Phoenix ICON wide-field infant fundus image.
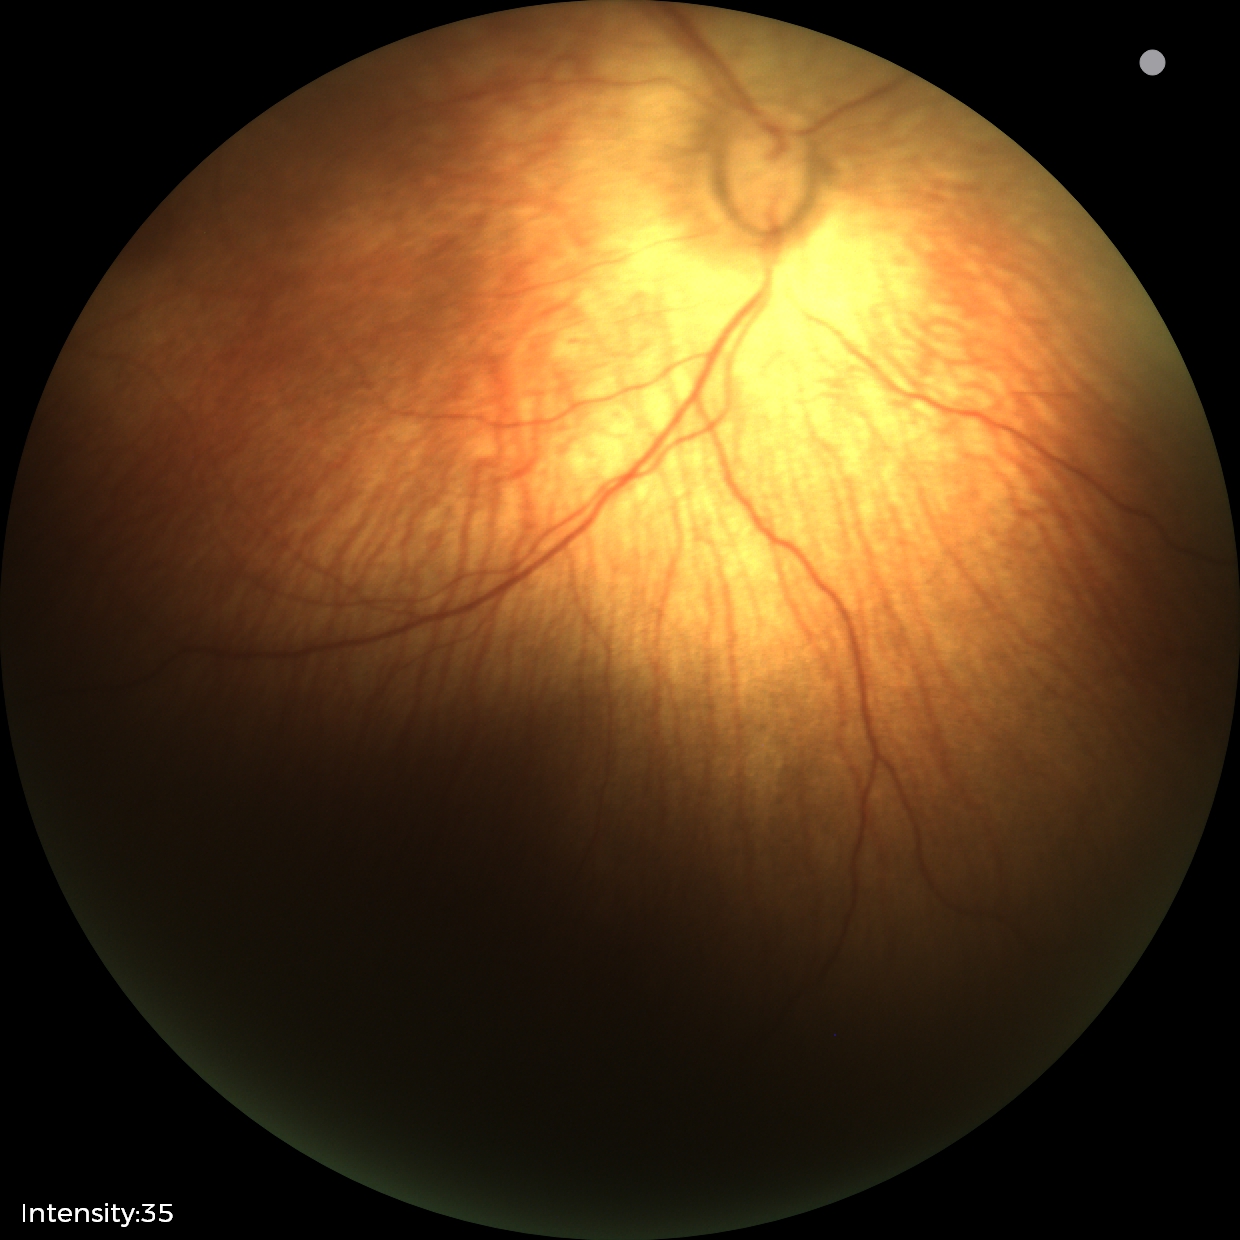 Diagnosis from this screening exam: status post retinopathy of prematurity.
Without plus disease.